Retinal fundus photograph; nonmydriatic; acquired with a NIDEK AFC-230.
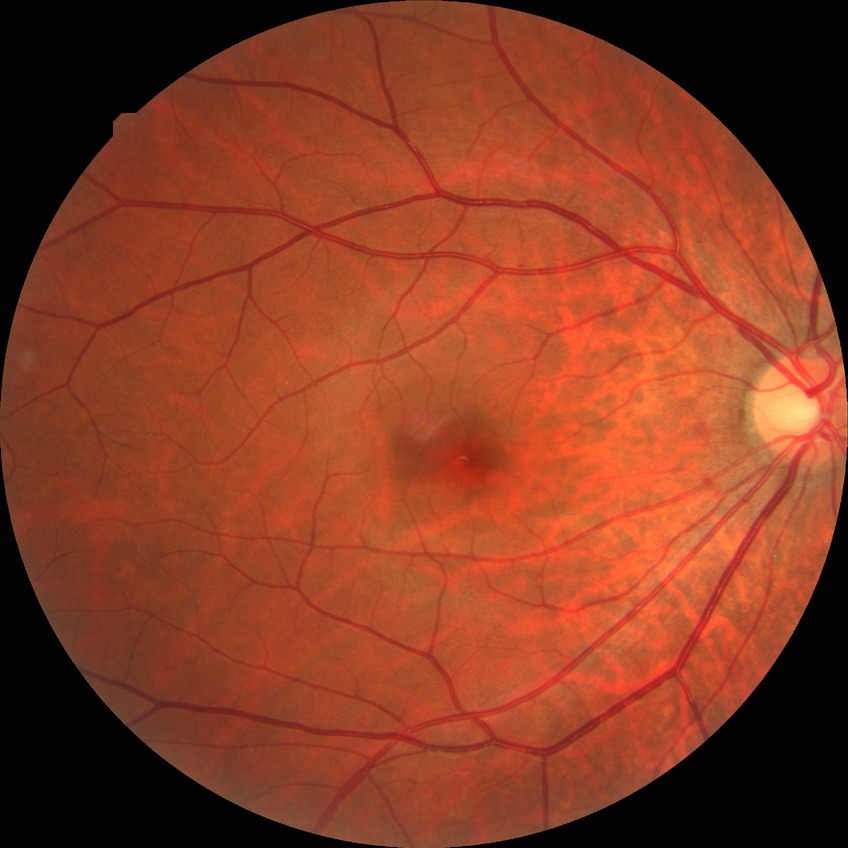

Findings:
• diabetic retinopathy (DR): simple diabetic retinopathy (SDR)